2352x1568 · fundus photo
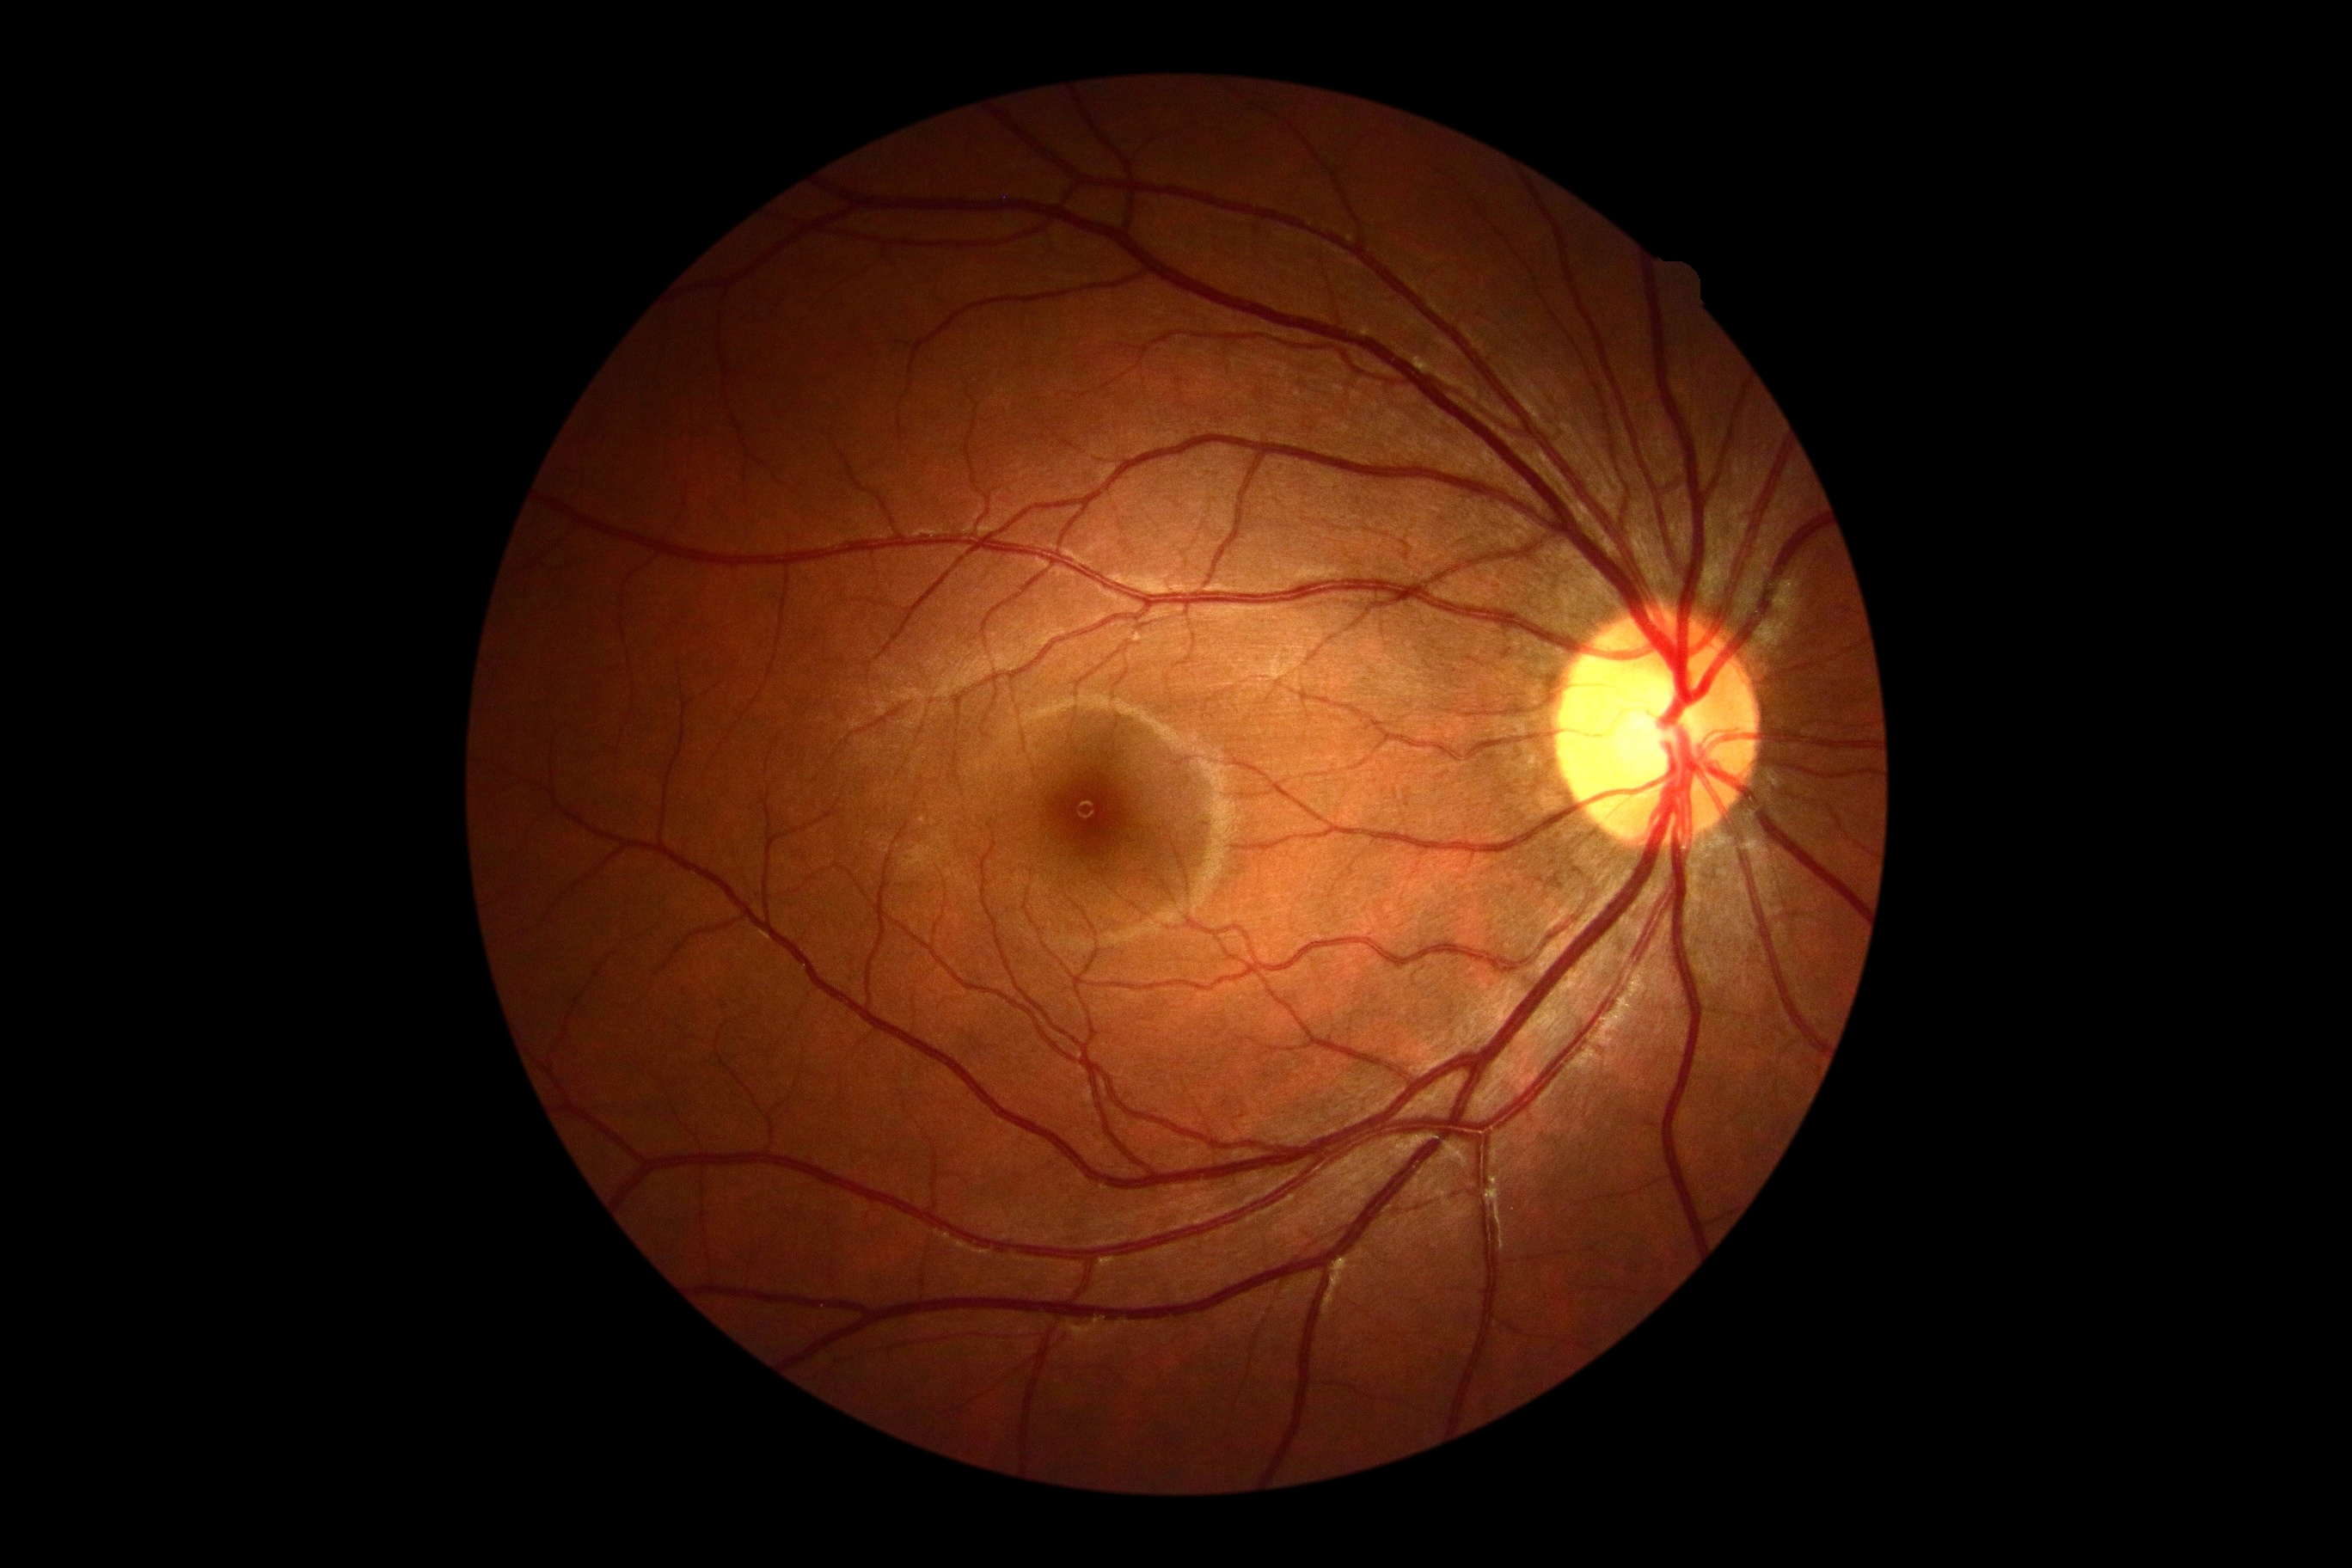 DR impression = no signs of DR, diabetic retinopathy (DR) = no apparent retinopathy (grade 0).